Wide-field contact fundus photograph of an infant:
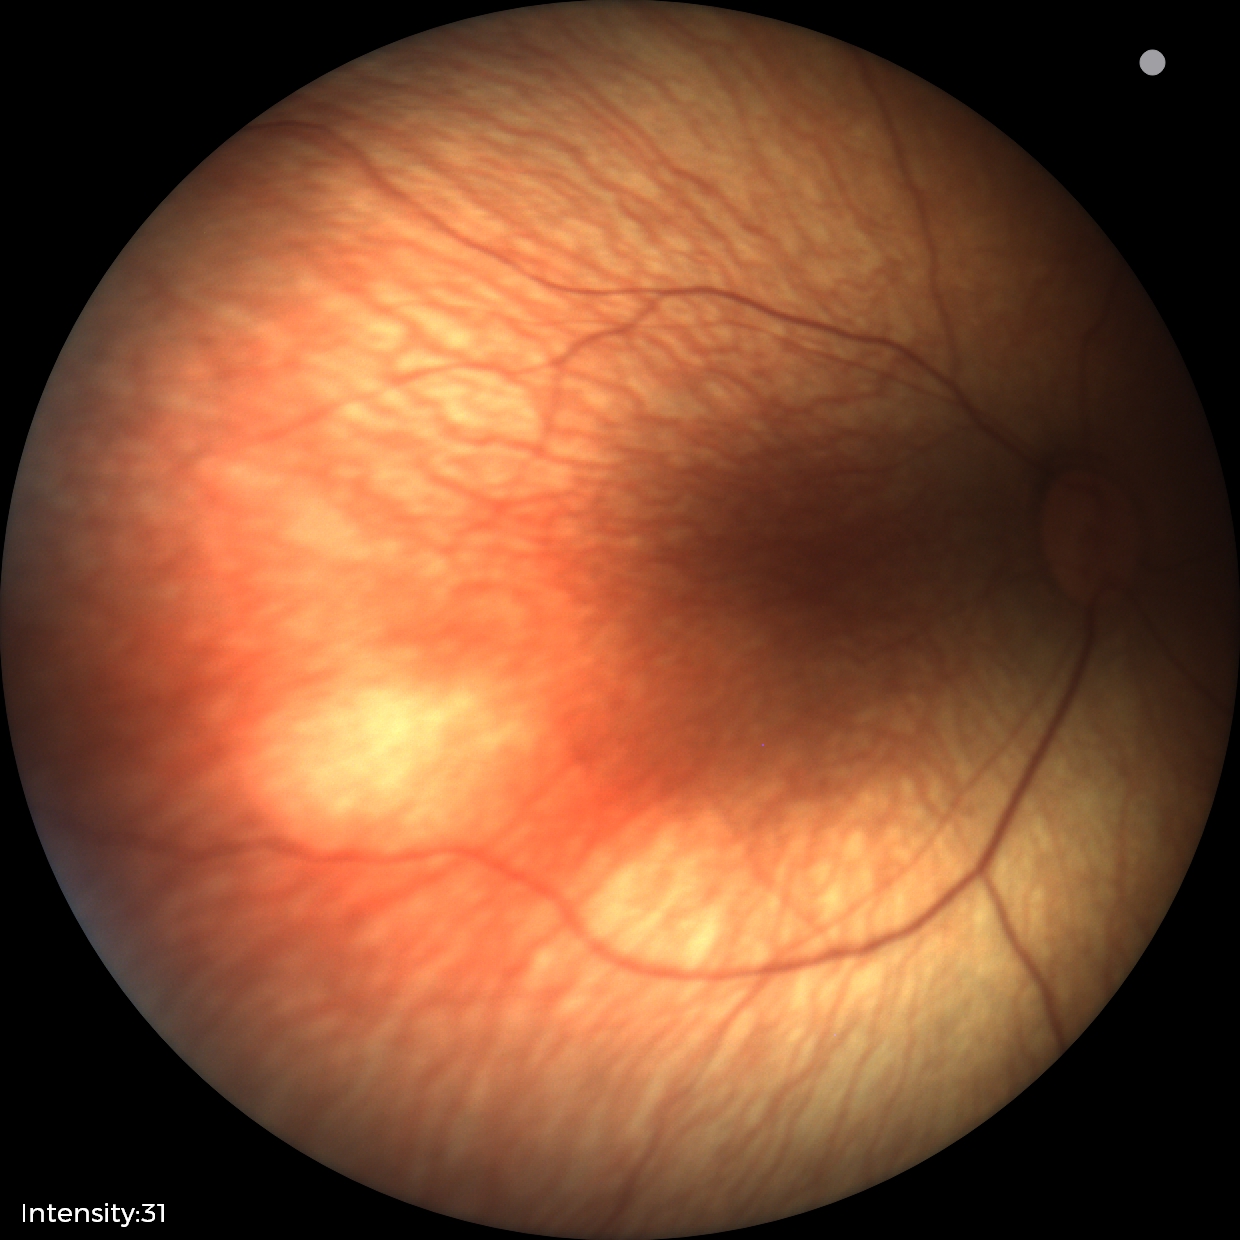
Examination with physiological retinal findings.